848 by 848 pixels, graded on the modified Davis scale: 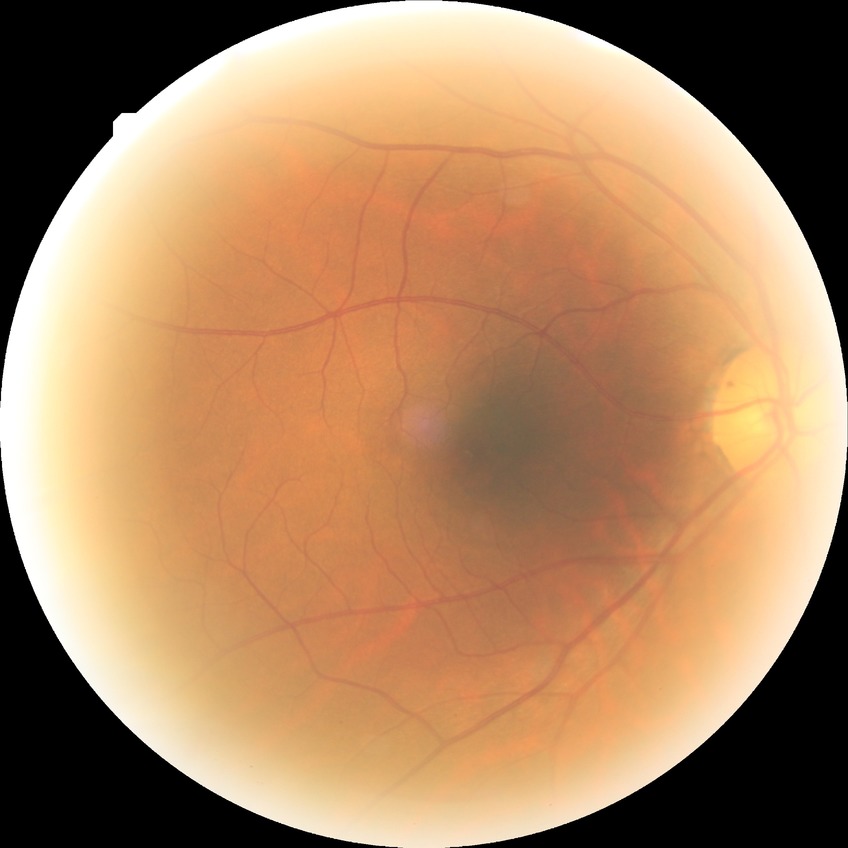
Assessment:
– diabetic retinopathy grade — no diabetic retinopathy